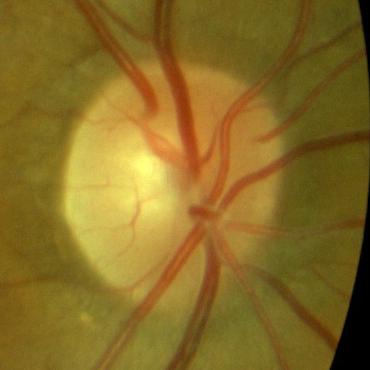
Optic disc appearance consistent with no glaucoma.